DR severity per modified Davis staging · fundus photo · 848x848px.
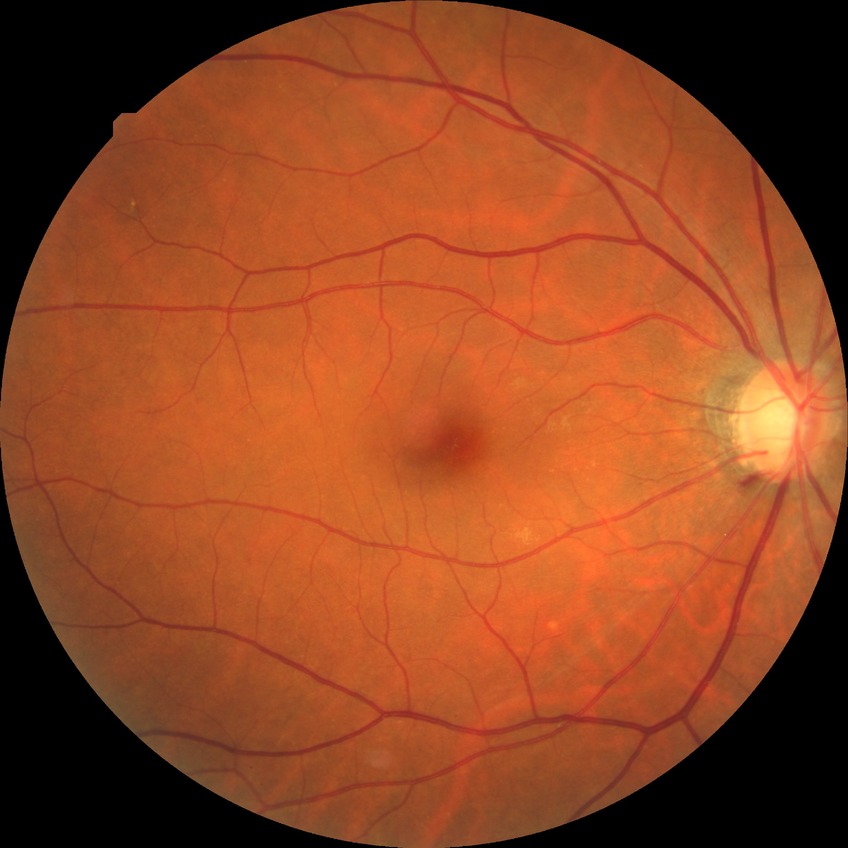

Diabetic retinopathy (DR) is no diabetic retinopathy (NDR).